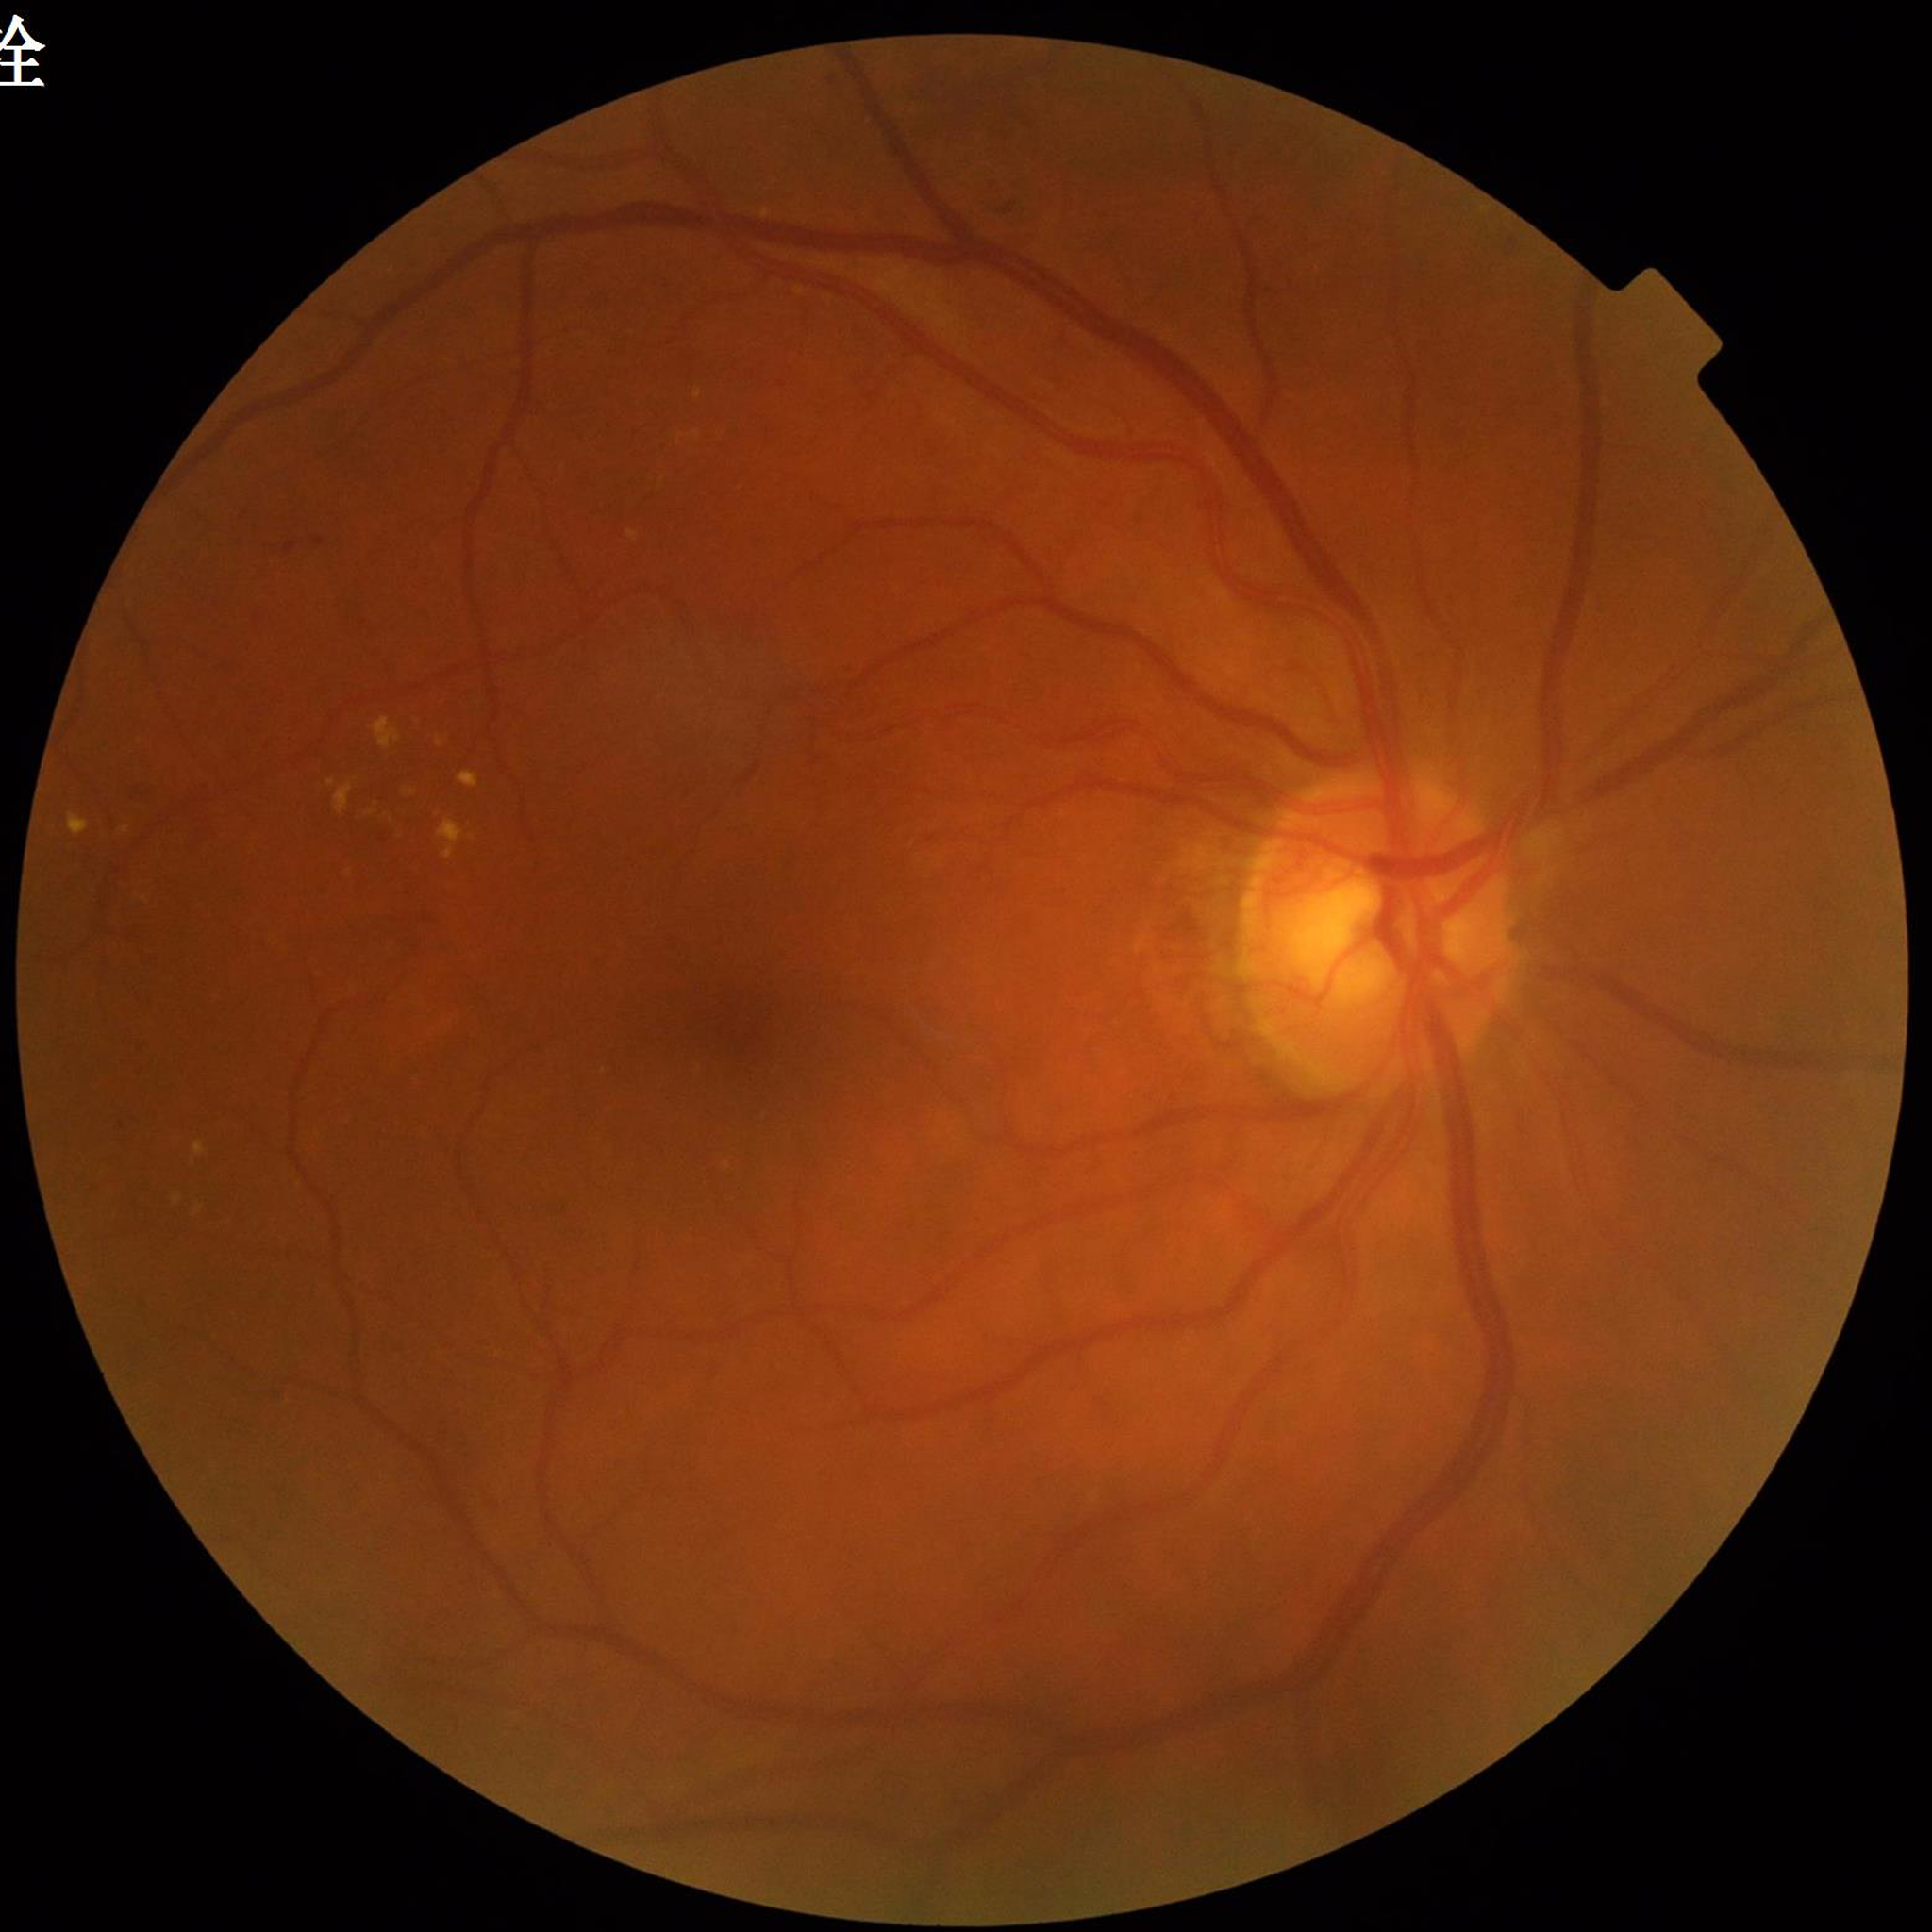
Clinical diagnosis: DR.